Modified Davis classification.
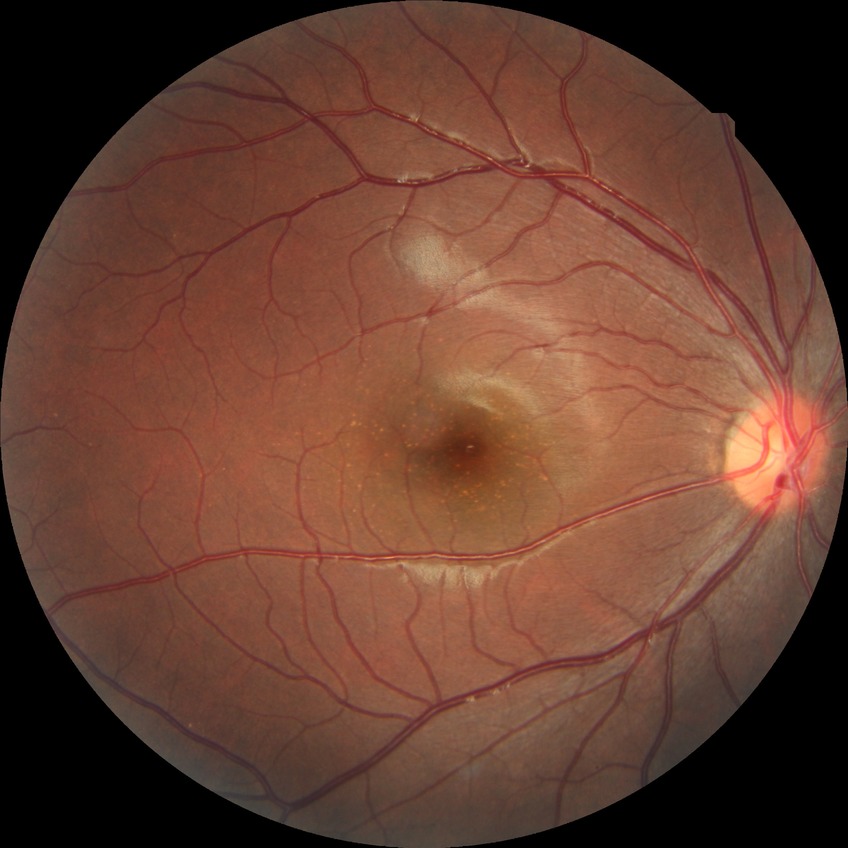
Modified Davis classification: no diabetic retinopathy.